CFP: 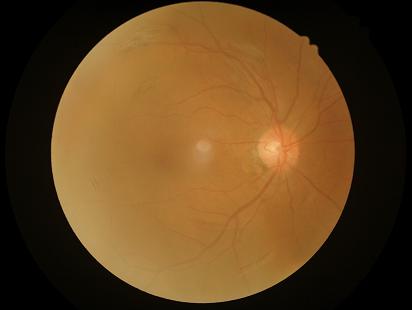
Focus: out of focus, structures indistinct | Overall quality: poor and difficult to use diagnostically | Illumination: even and well-balanced | Contrast: good dynamic range.